Retinal fundus photograph, image size 848x848, diabetic retinopathy graded by the modified Davis classification, no pharmacologic dilation — 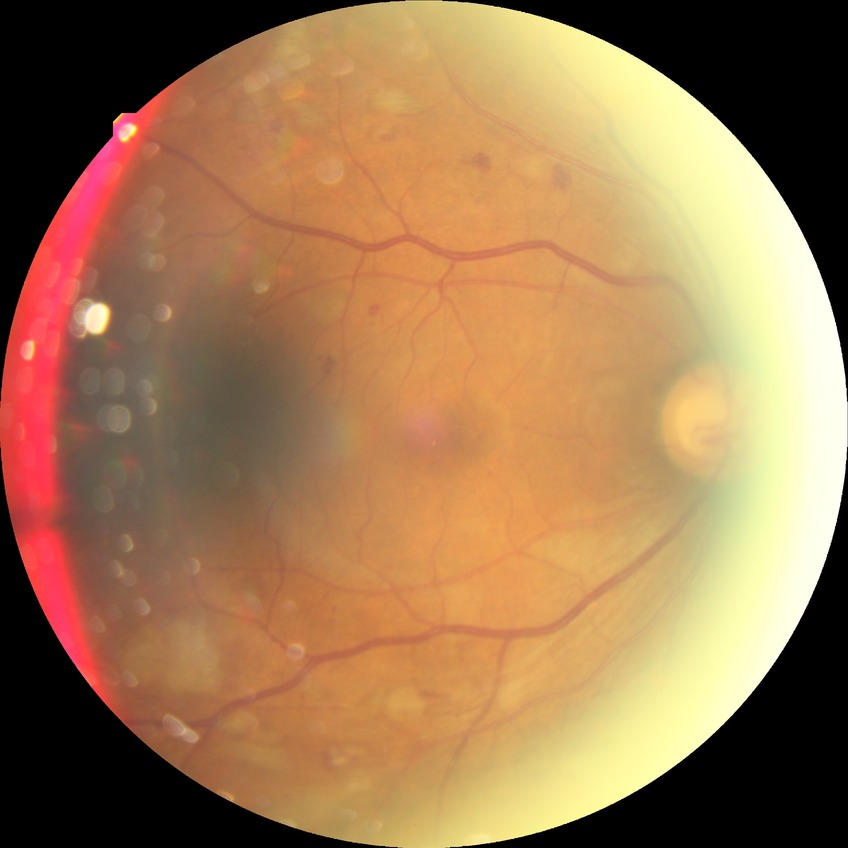
Diabetic retinopathy (DR): pre-proliferative diabetic retinopathy (PPDR).